Posterior pole field covering the optic disc and macula.
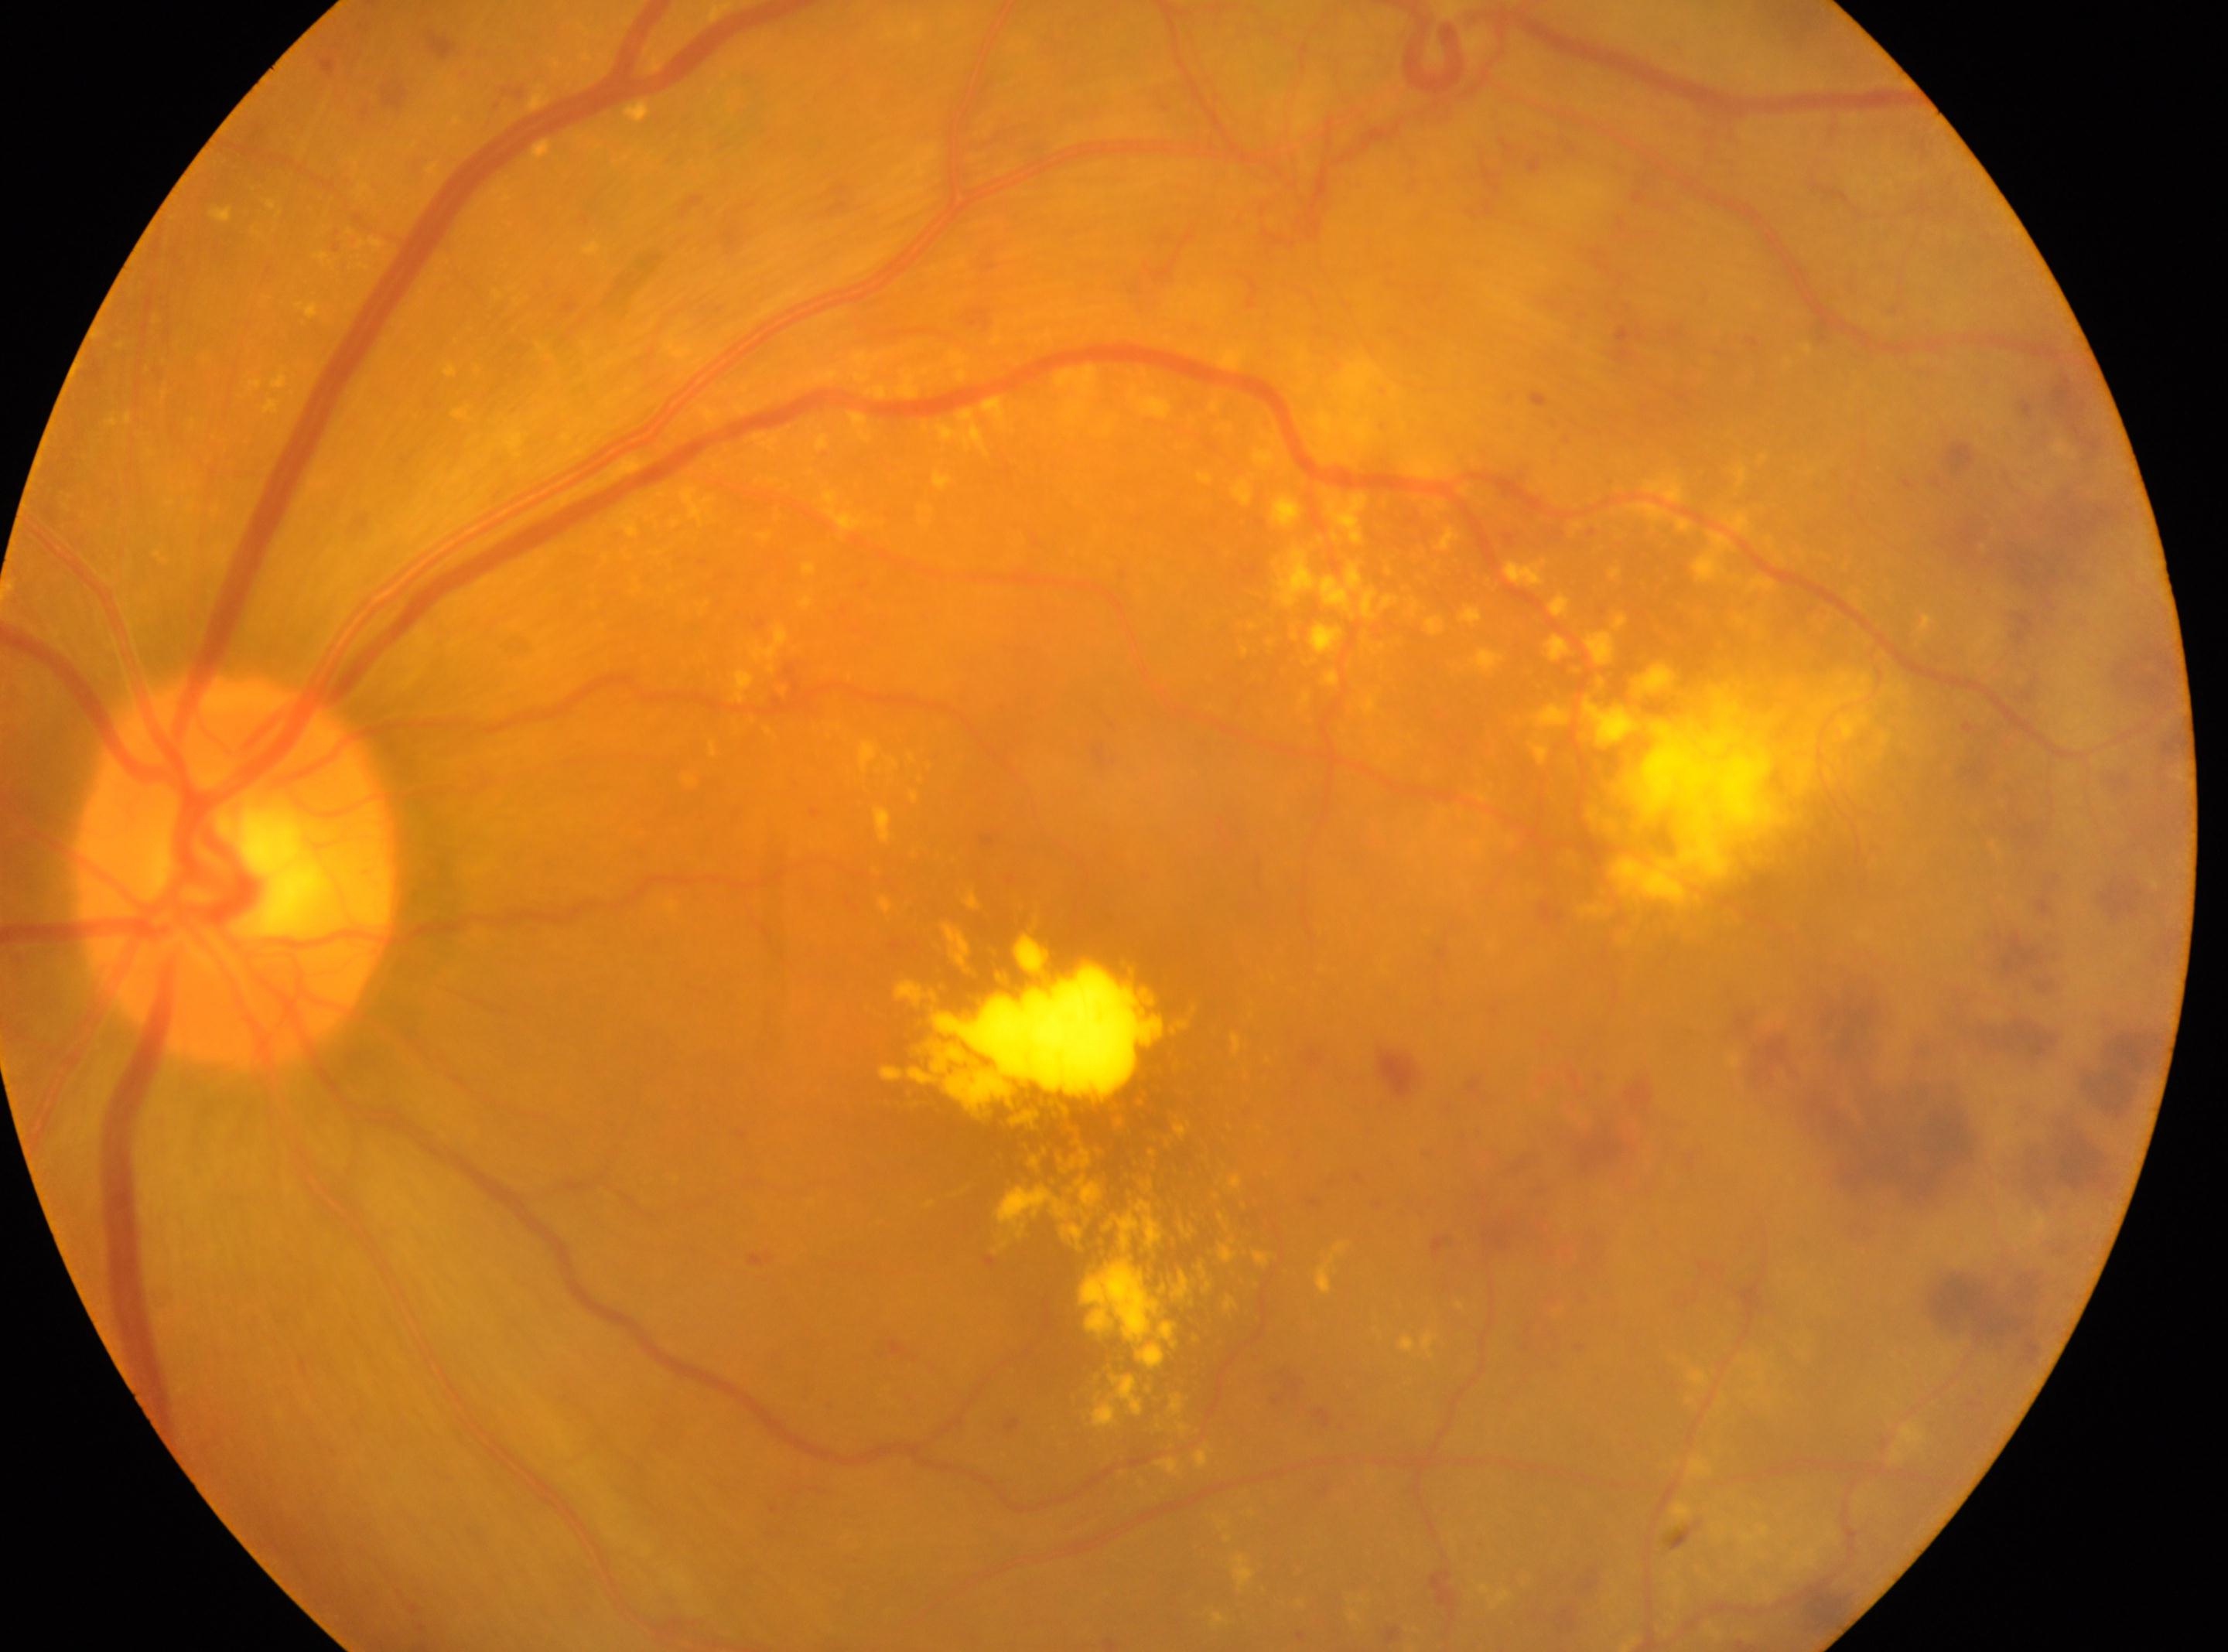 Findings:
- disc center: 232px, 871px
- DR severity: 4
- eye: OS
- fovea center: 1102px, 1132px